Camera: Remidio Fundus on Phone (FOP) camera.
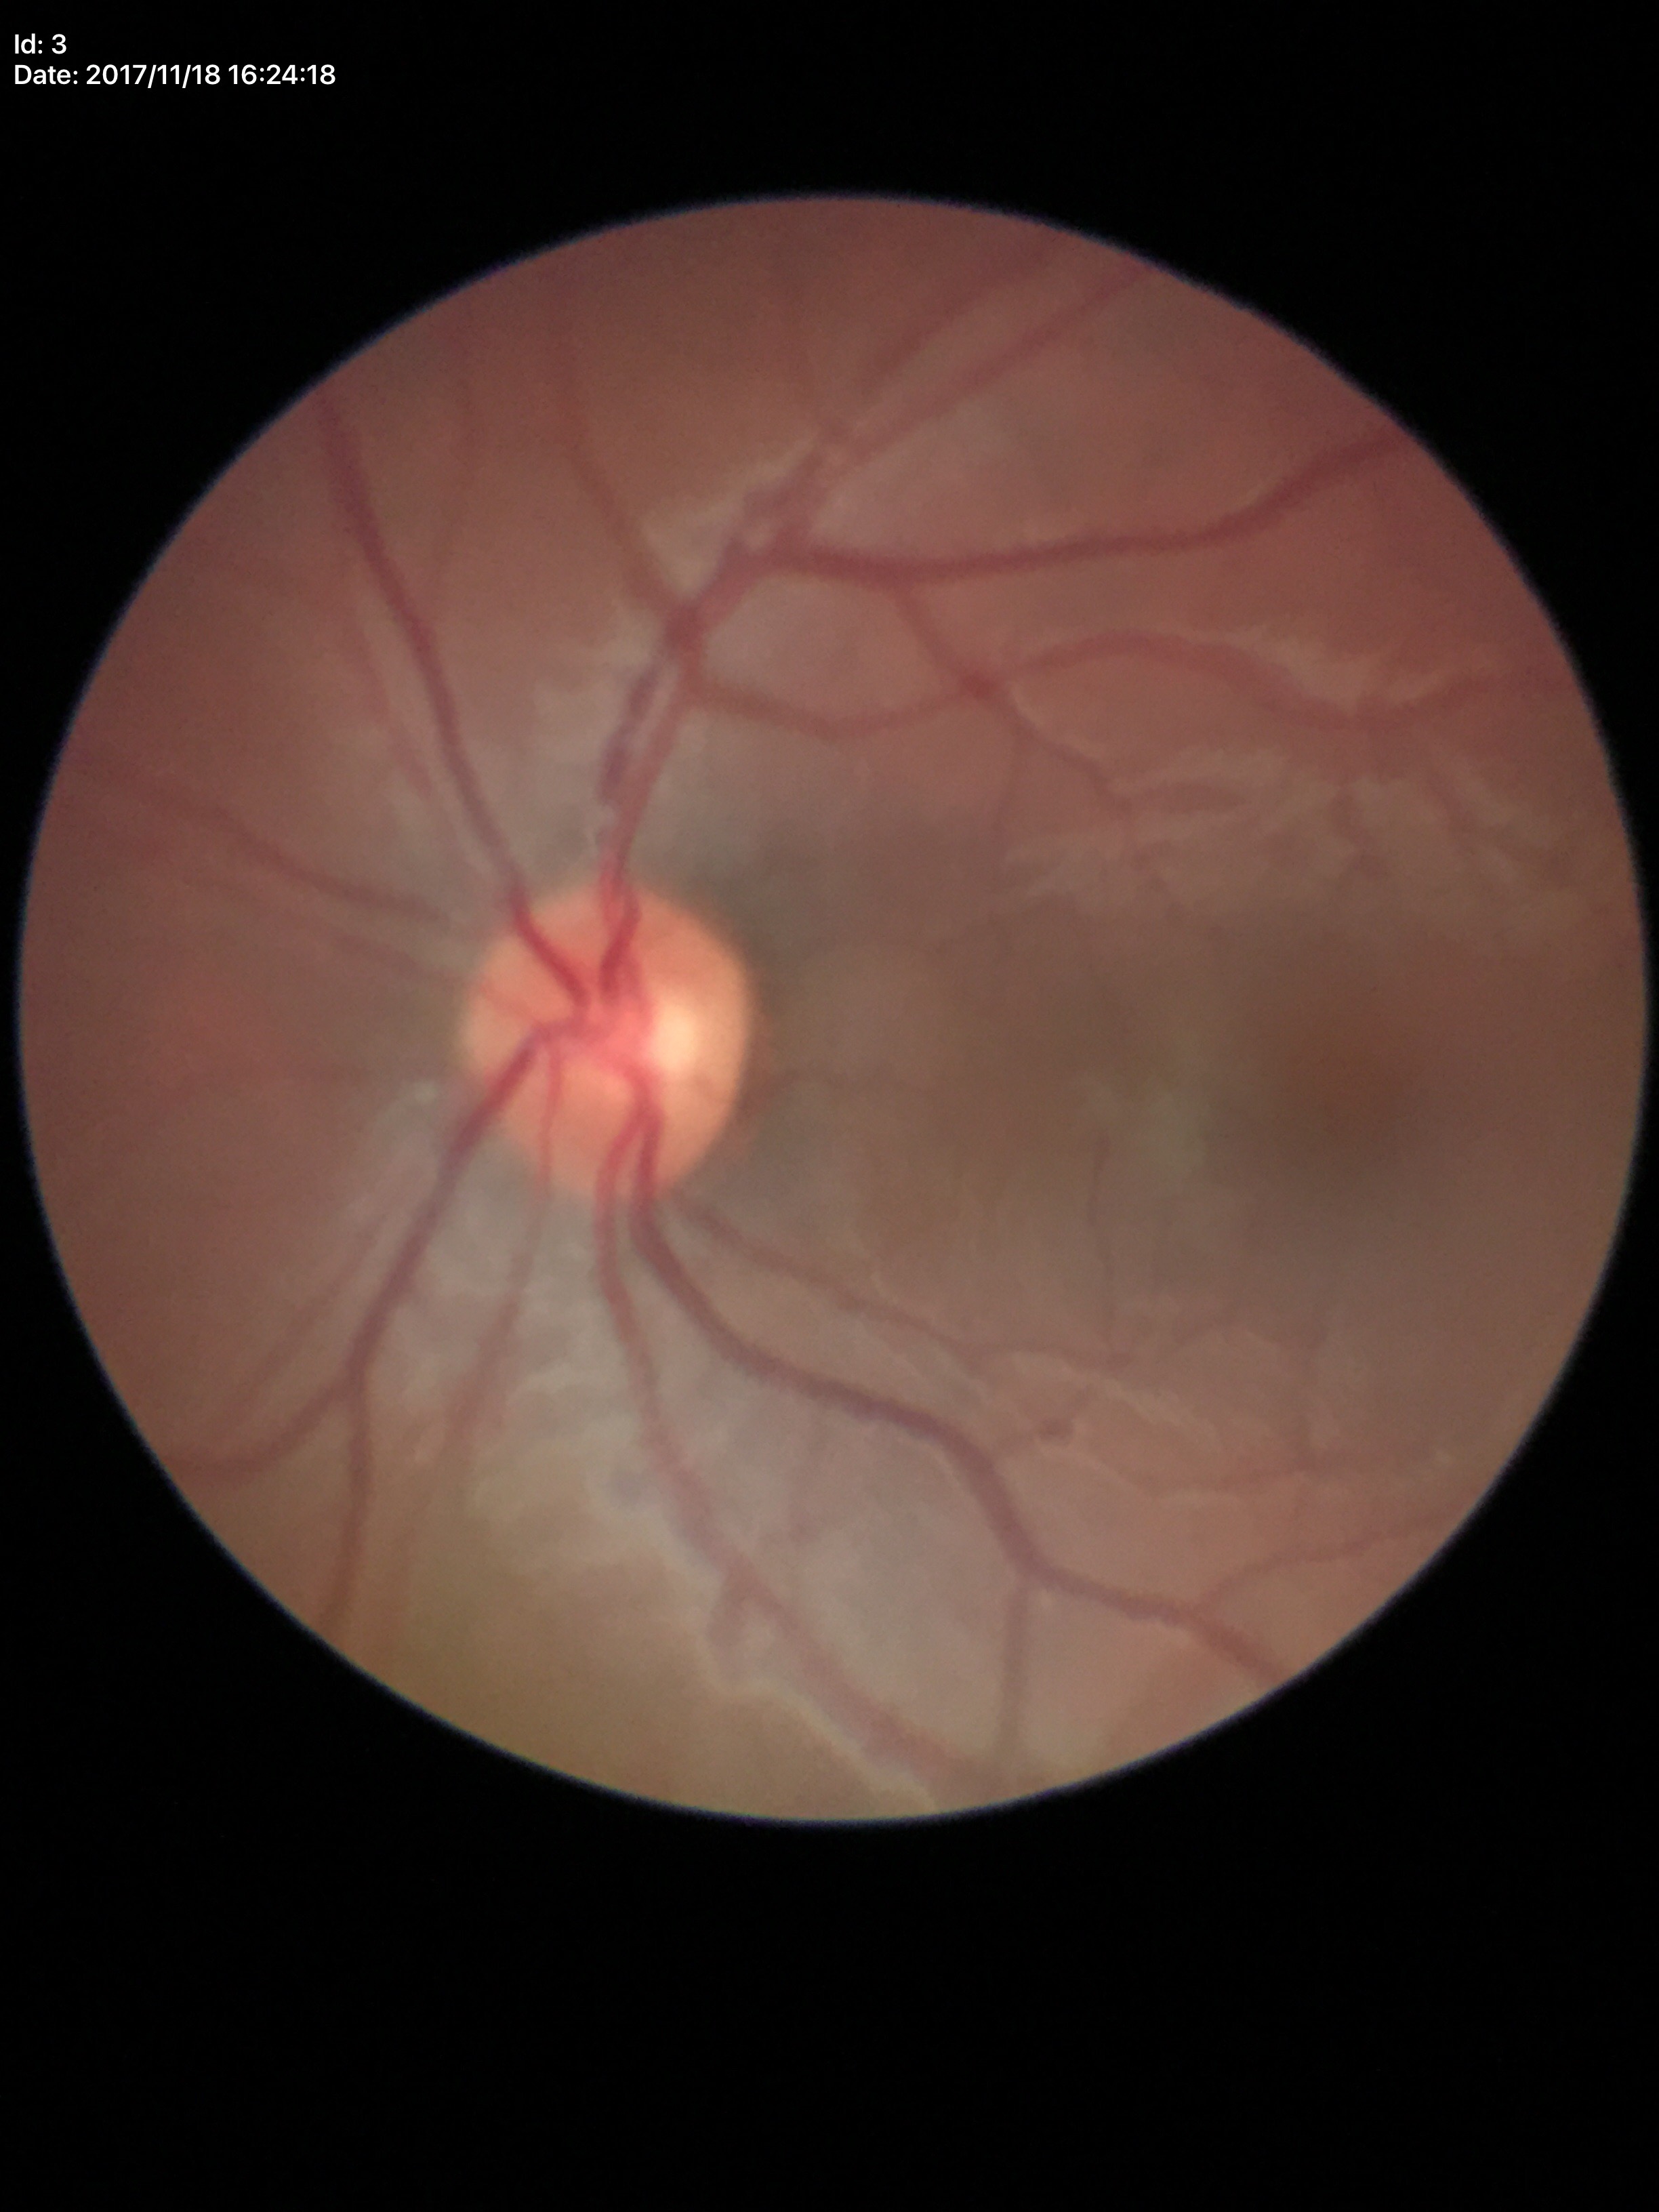 Glaucoma screening impression: not suspect. Vertical cup-to-disc ratio (VCDR) is 0.50. Horizontal cup-to-disc ratio (HCDR) of 0.54.